2212 by 1659 pixels
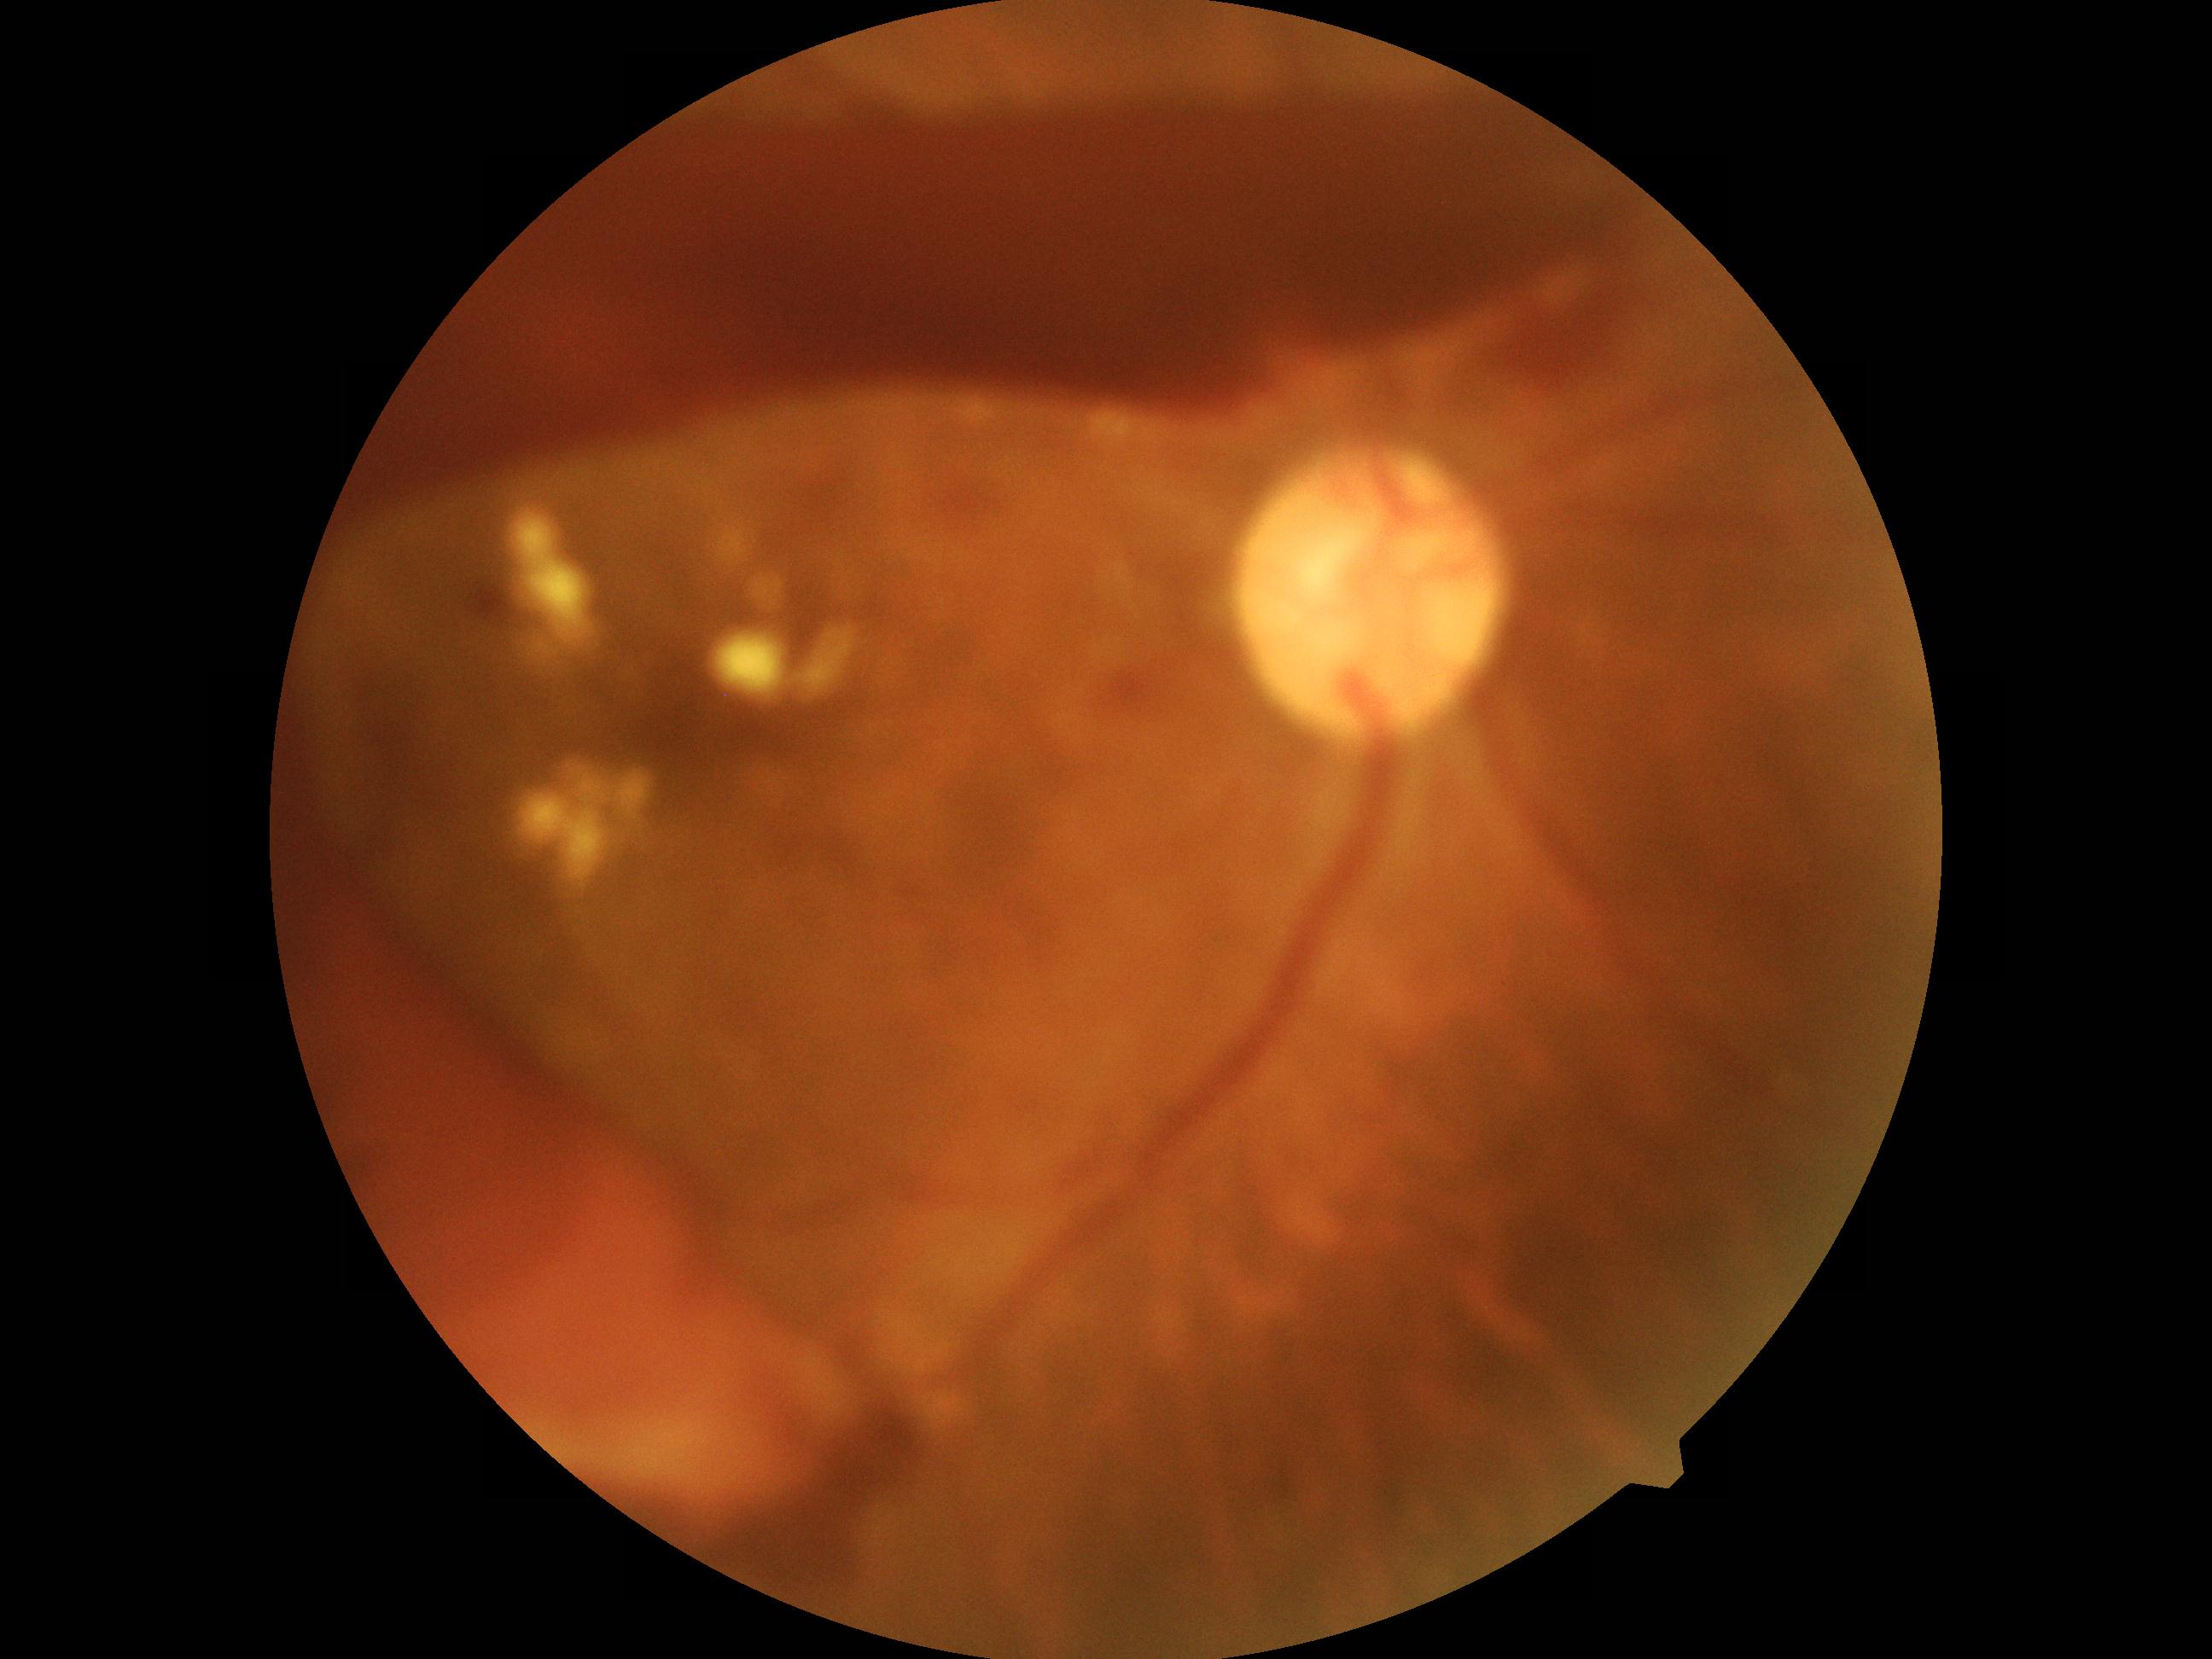

DR severity: 4.